2048 by 1536 pixels — 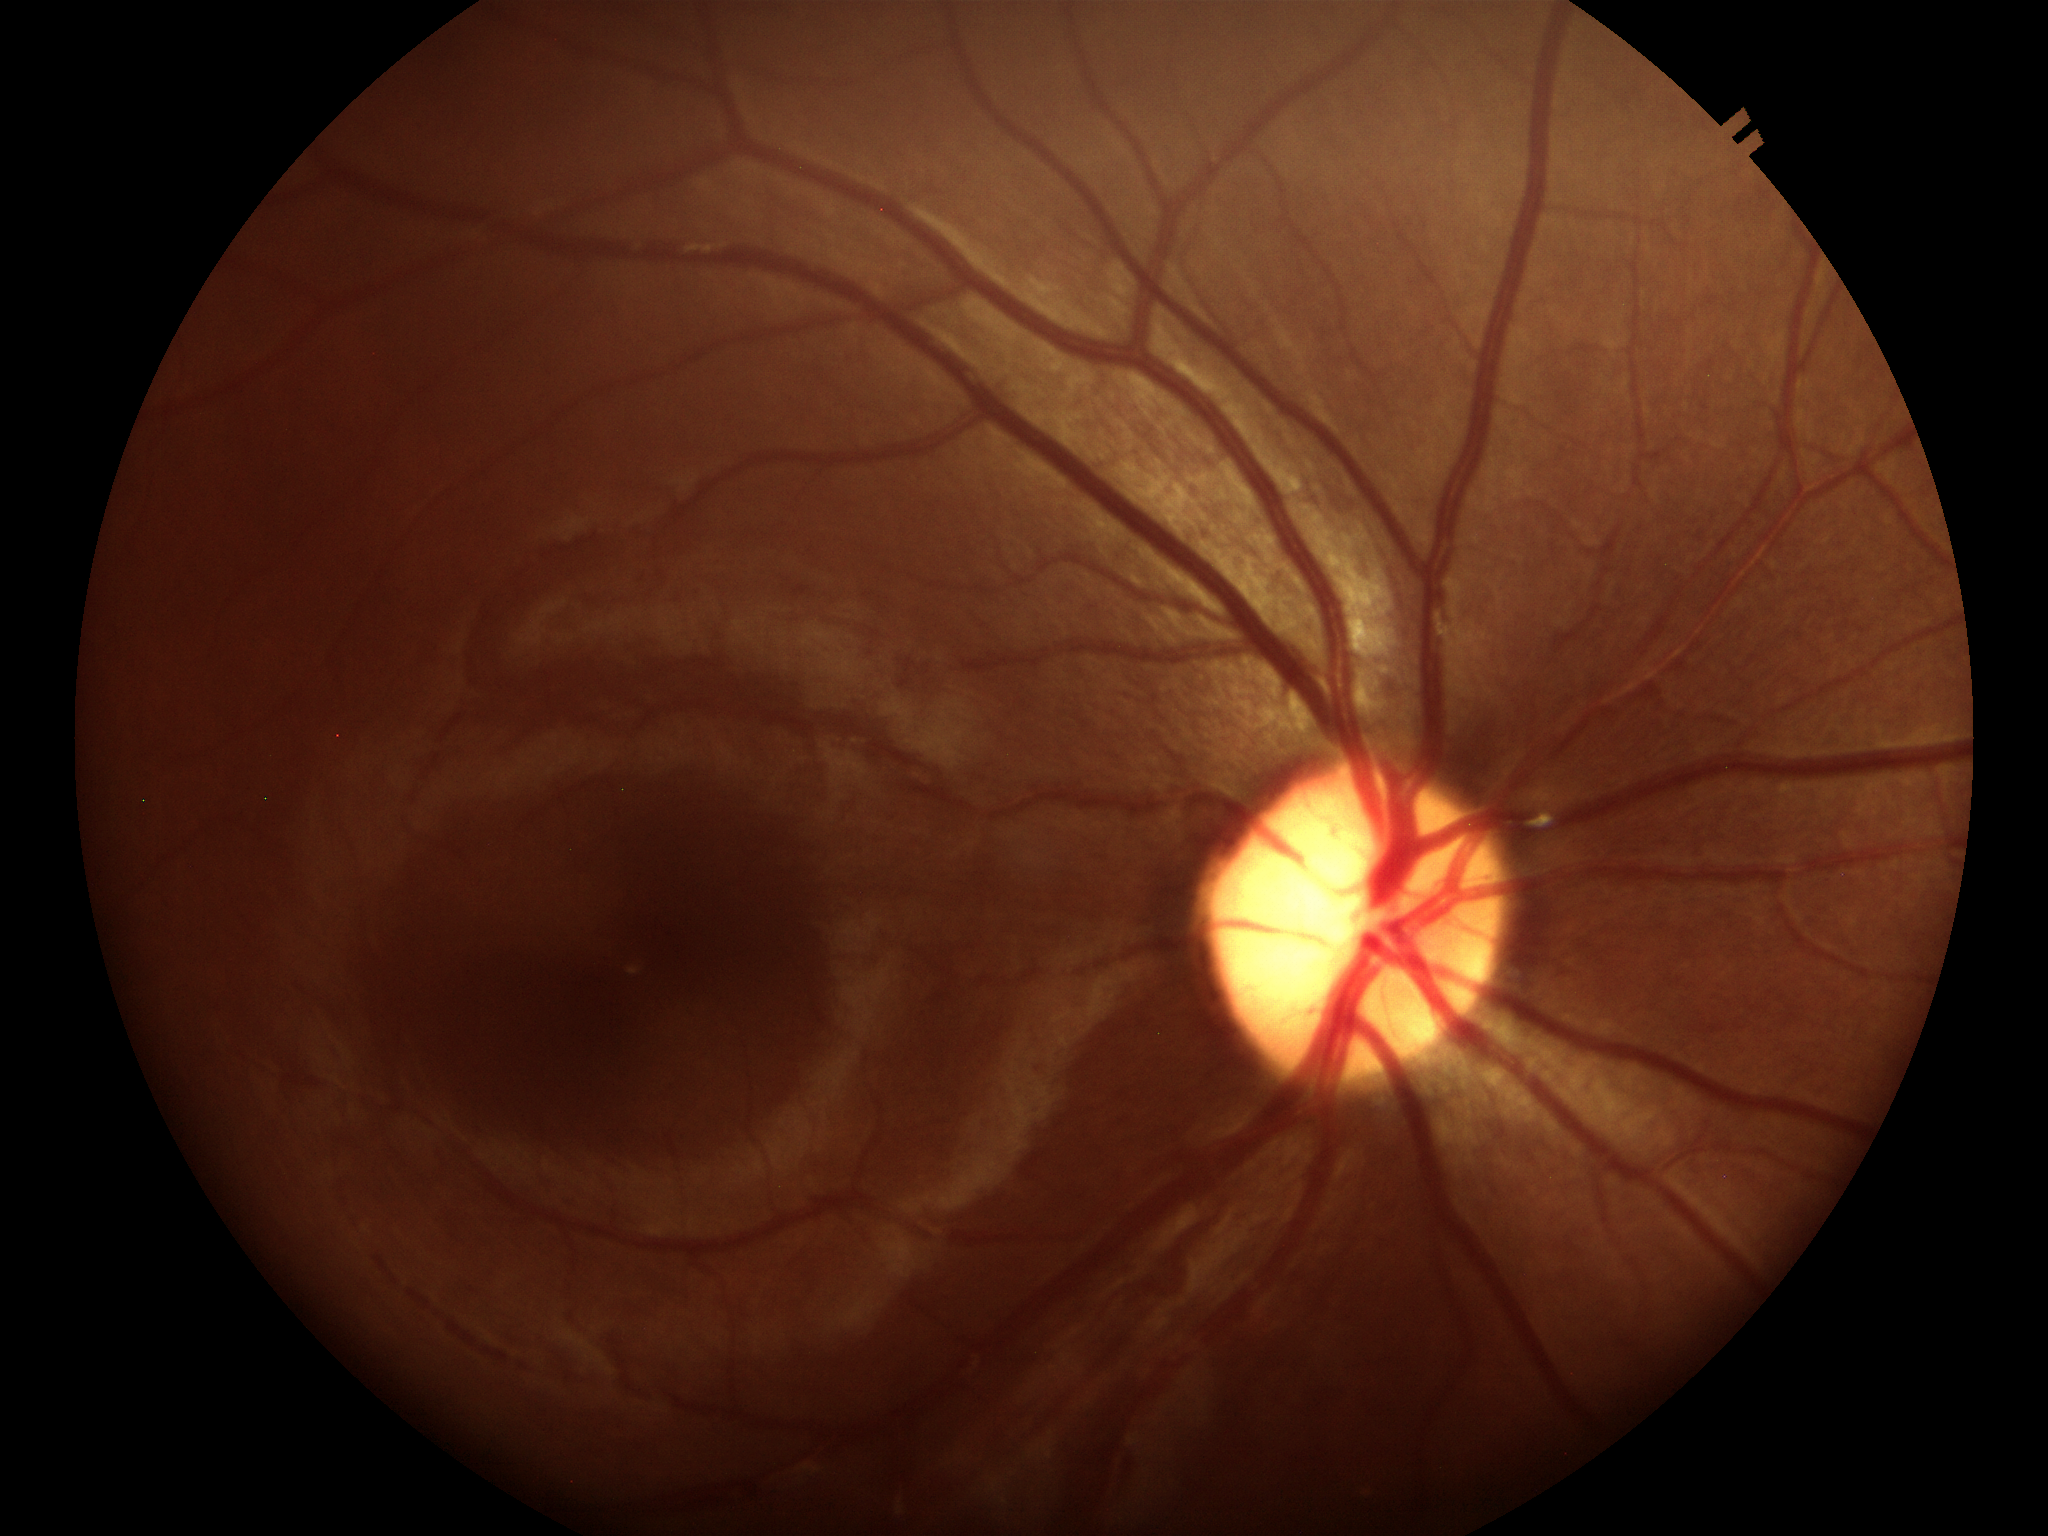

Not suspicious for glaucoma (5/5 ophthalmologists in agreement). Vertical CDR: 0.51.